Phoenix ICON, 100° FOV · 1240x1240px · Phoenix ICON wide-field infant fundus image
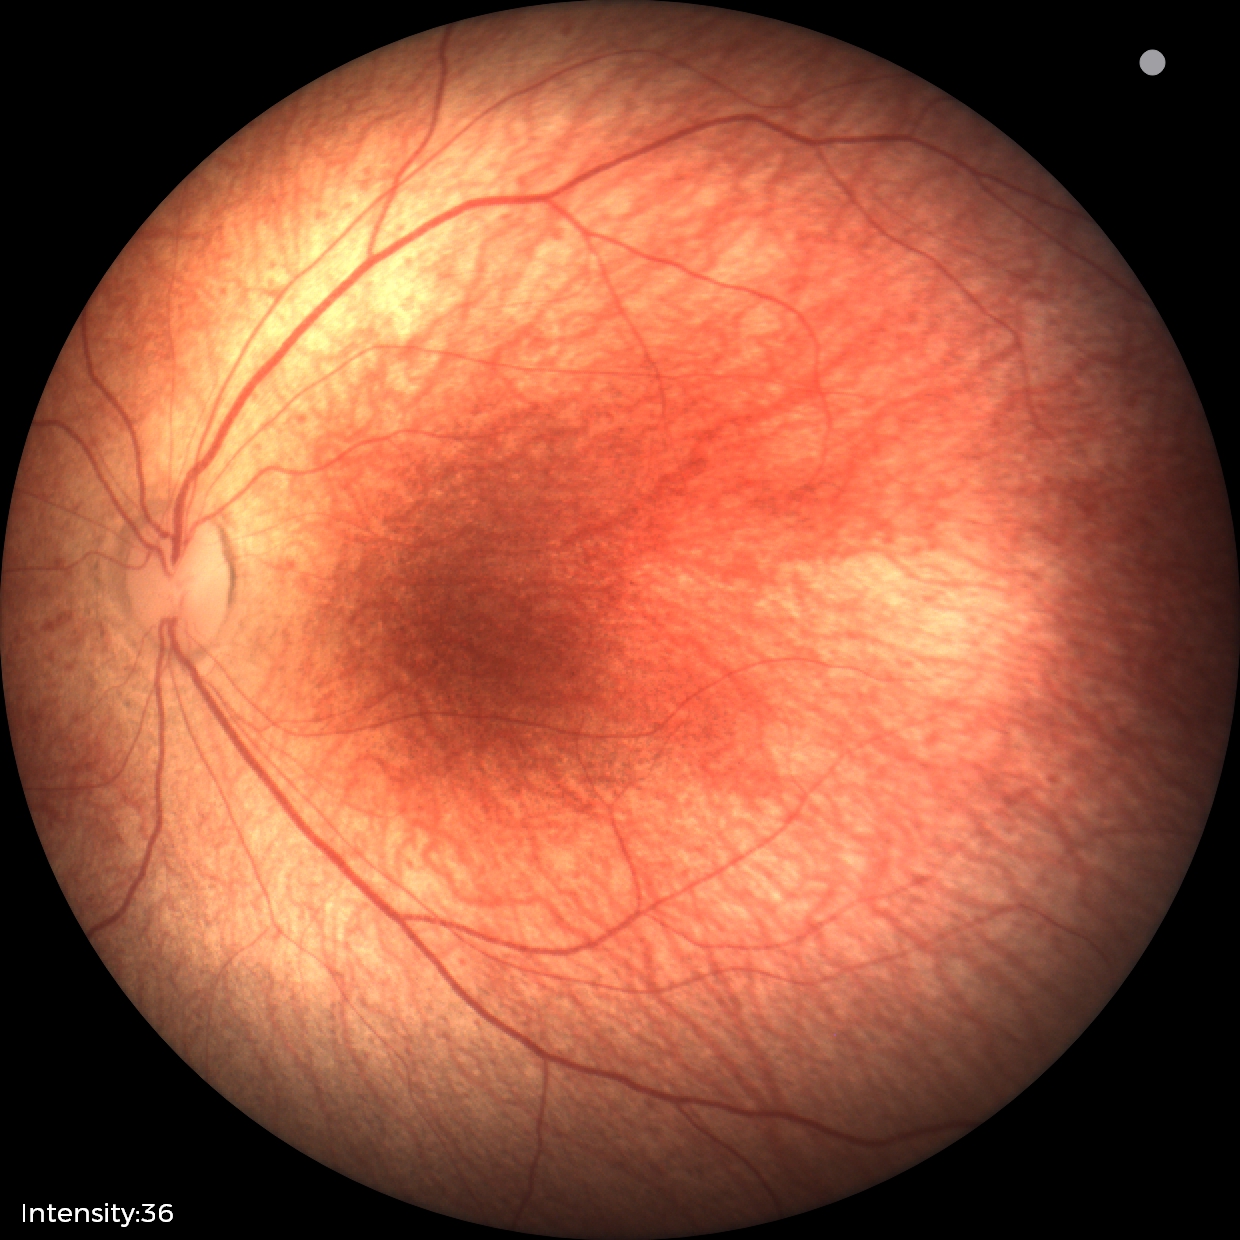
Assessment = normal.